Fundus photo.
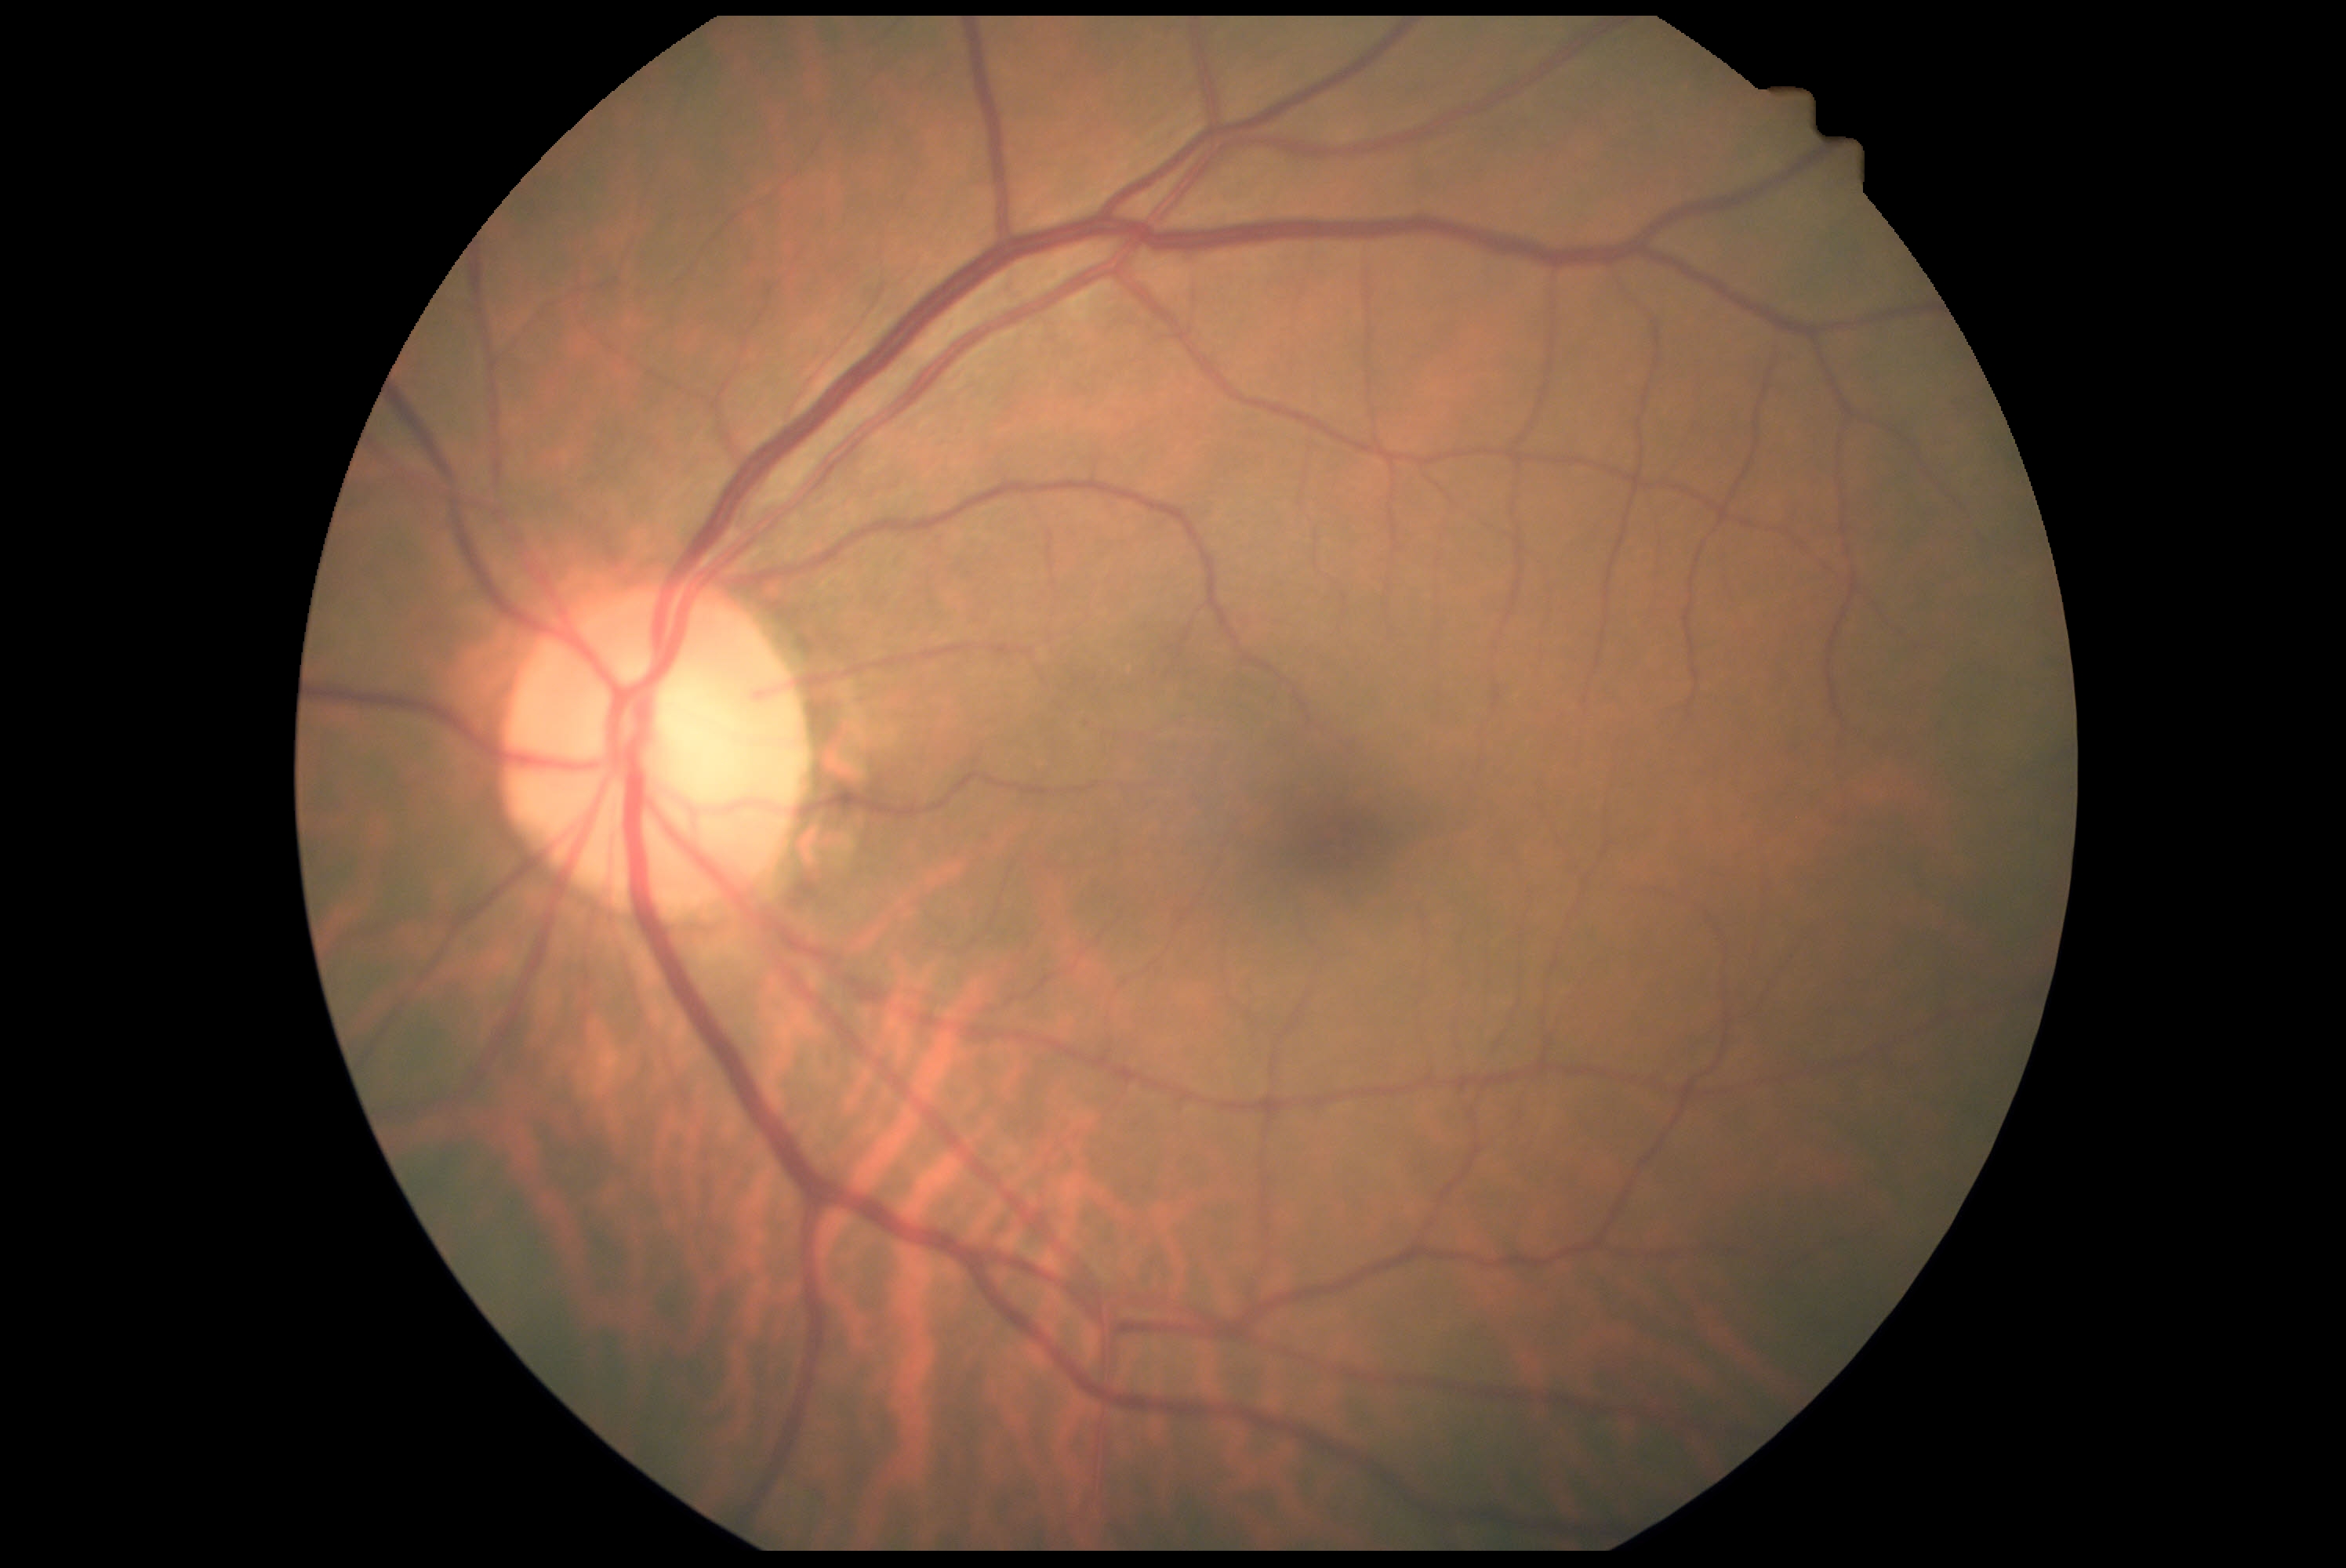 DR: no apparent diabetic retinopathy (grade 0) — no visible signs of diabetic retinopathy.